Pediatric wide-field fundus photograph
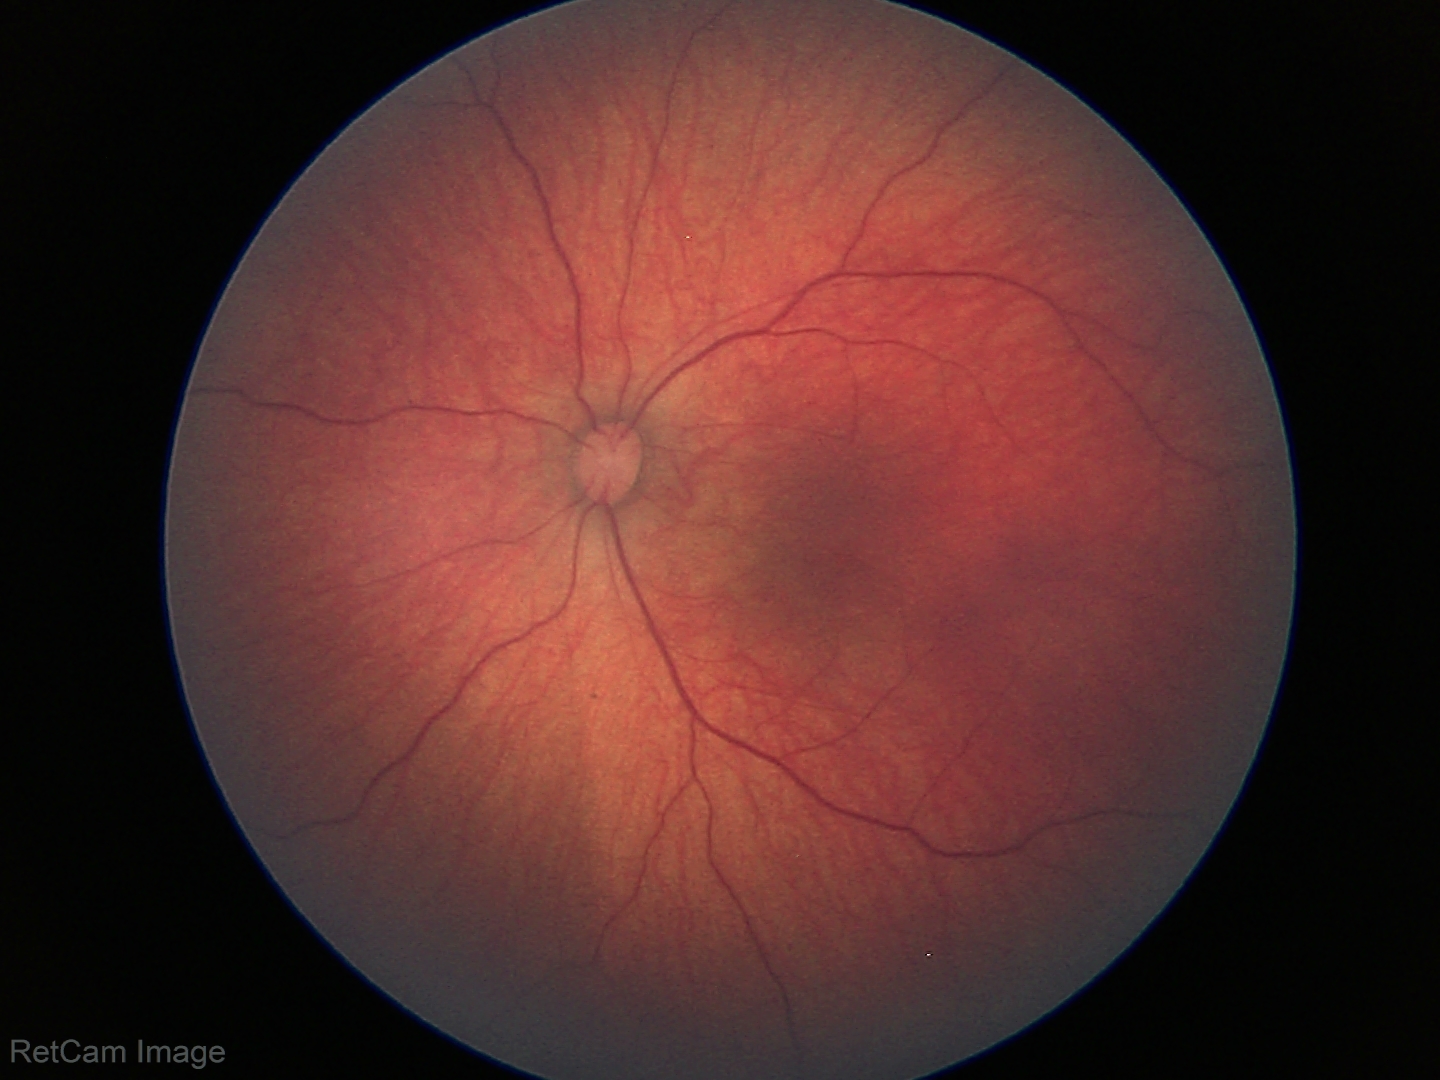 From an examination with diagnosis of retinal hemorrhages.